UWF retinal mosaic — 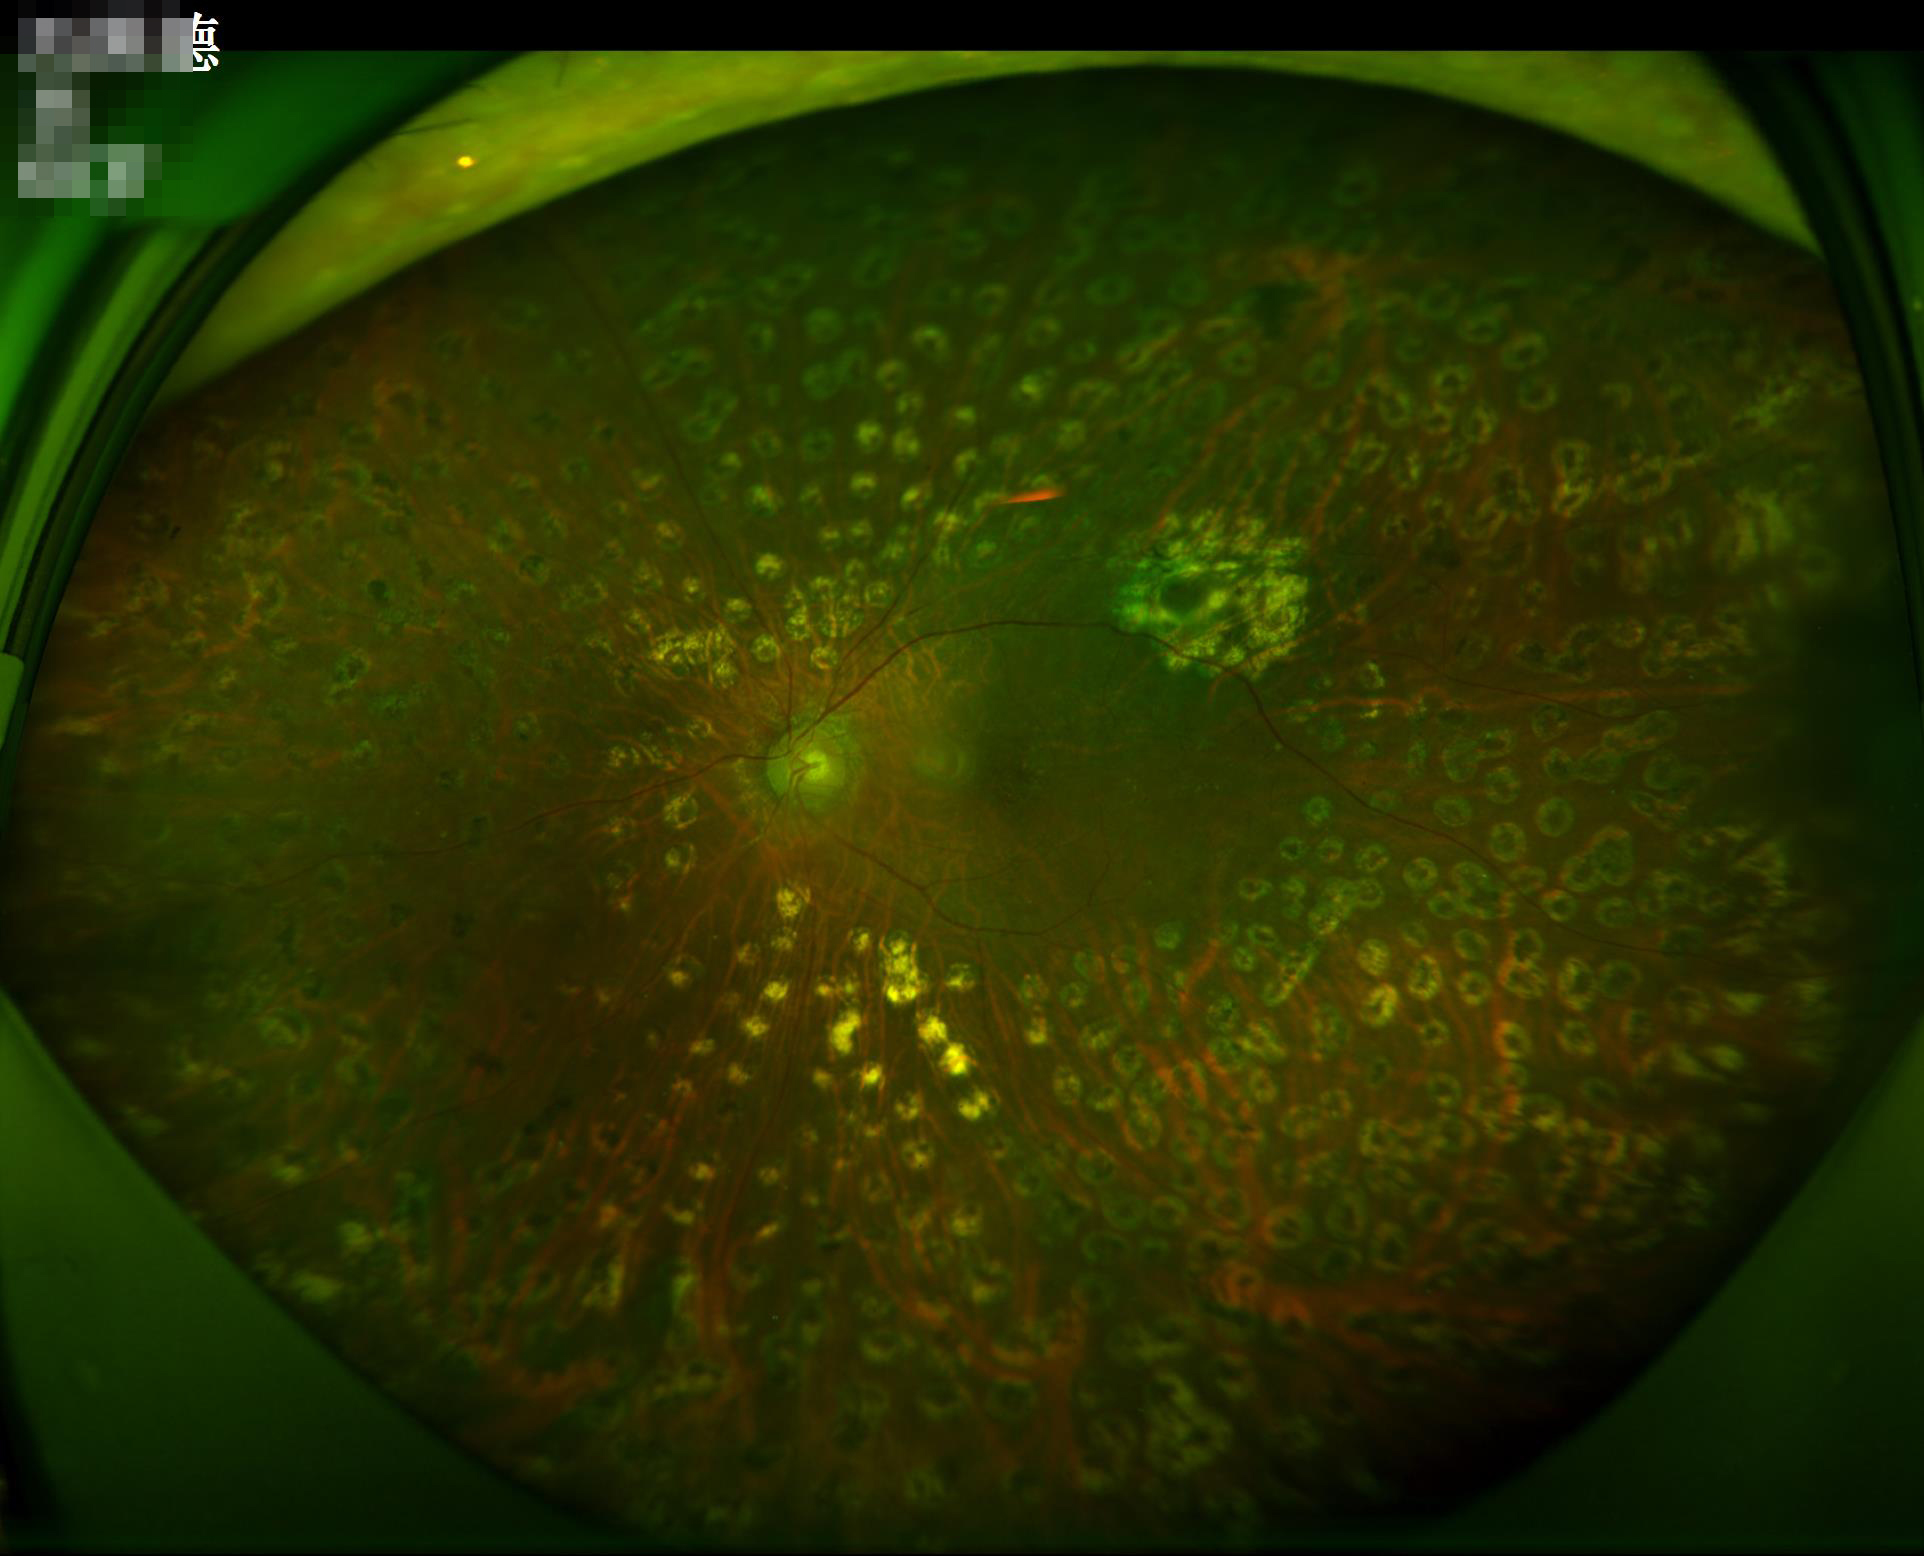 Quality assessment: contrast: satisfactory; overall: adequate; sharpness: in focus; illumination: suboptimal.